Fundus photo
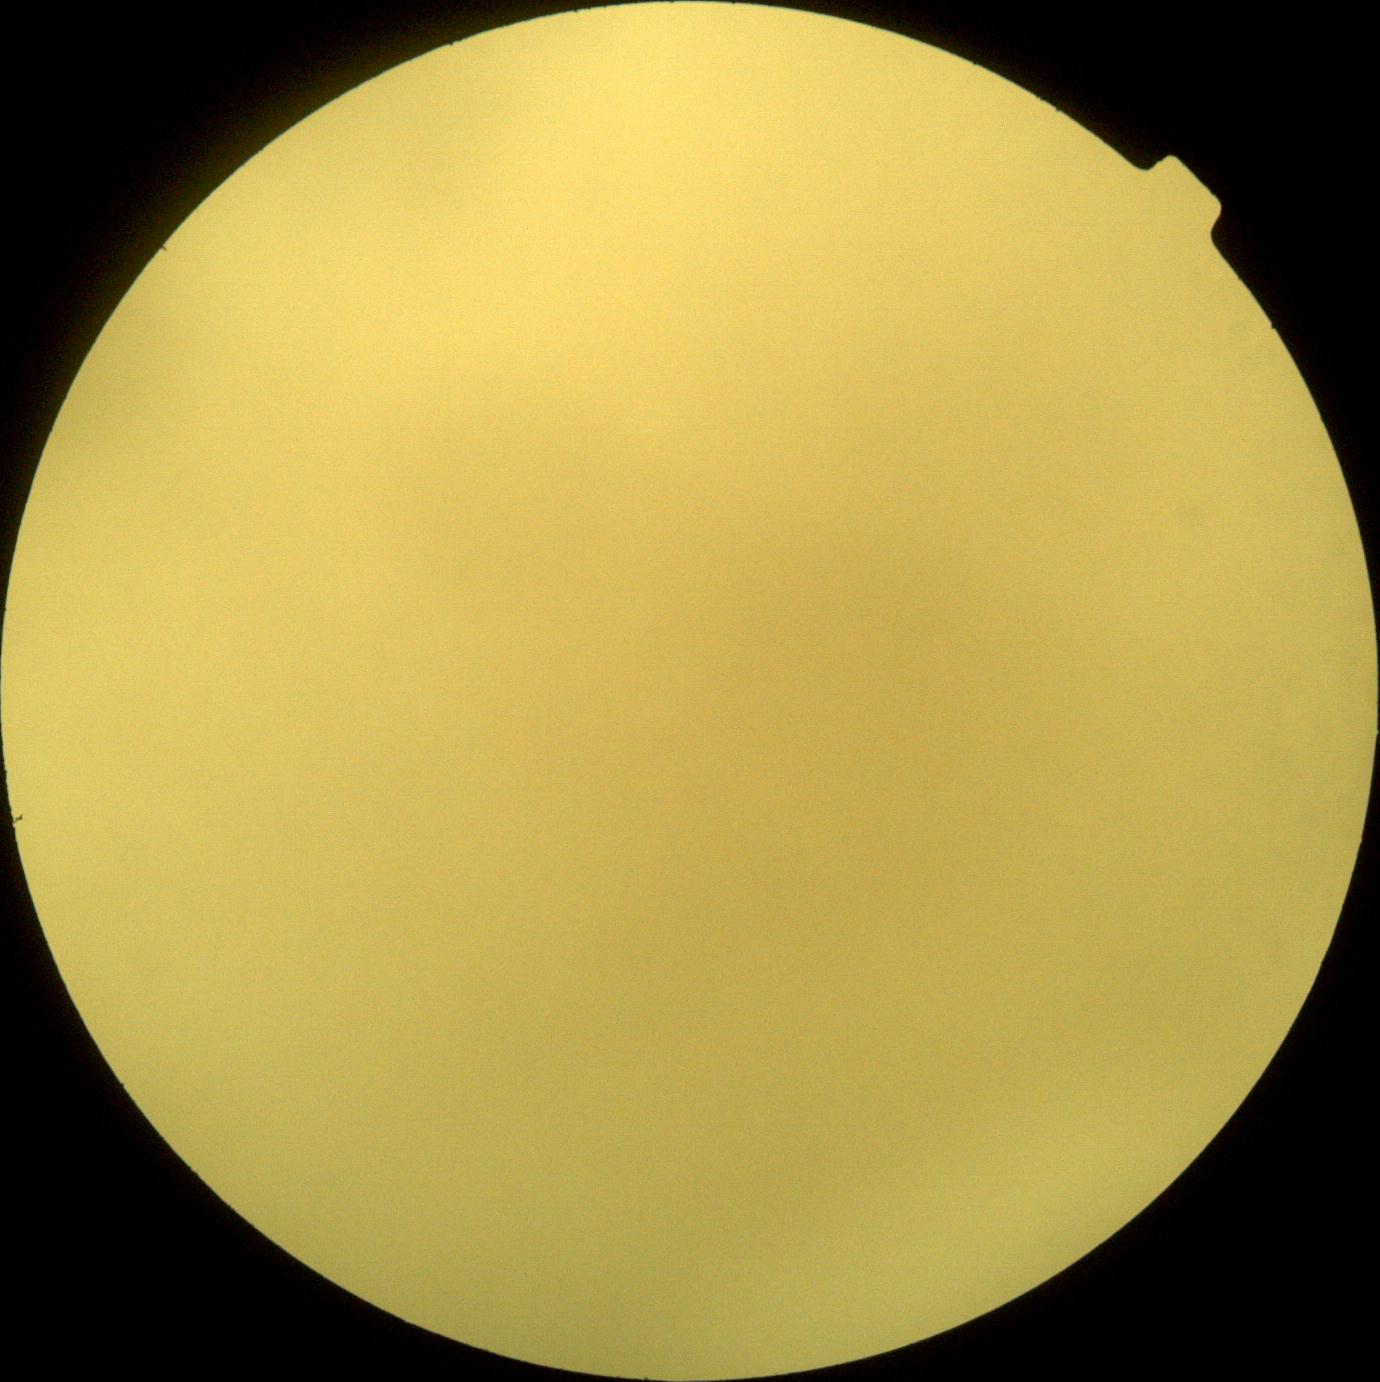

diabetic retinopathy (DR): ungradable.